Davis DR grading. Acquired with a NIDEK AFC-230. Without pupil dilation.
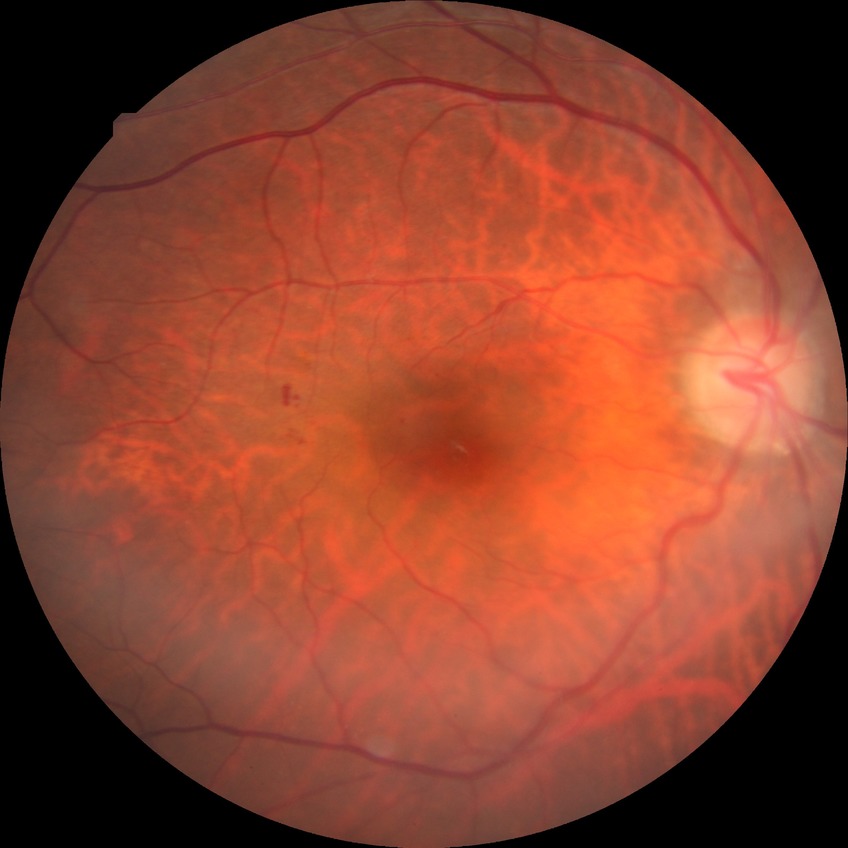

modified Davis grading: simple diabetic retinopathy.